2352x1568 · fundus photo · FOV: 45 degrees.
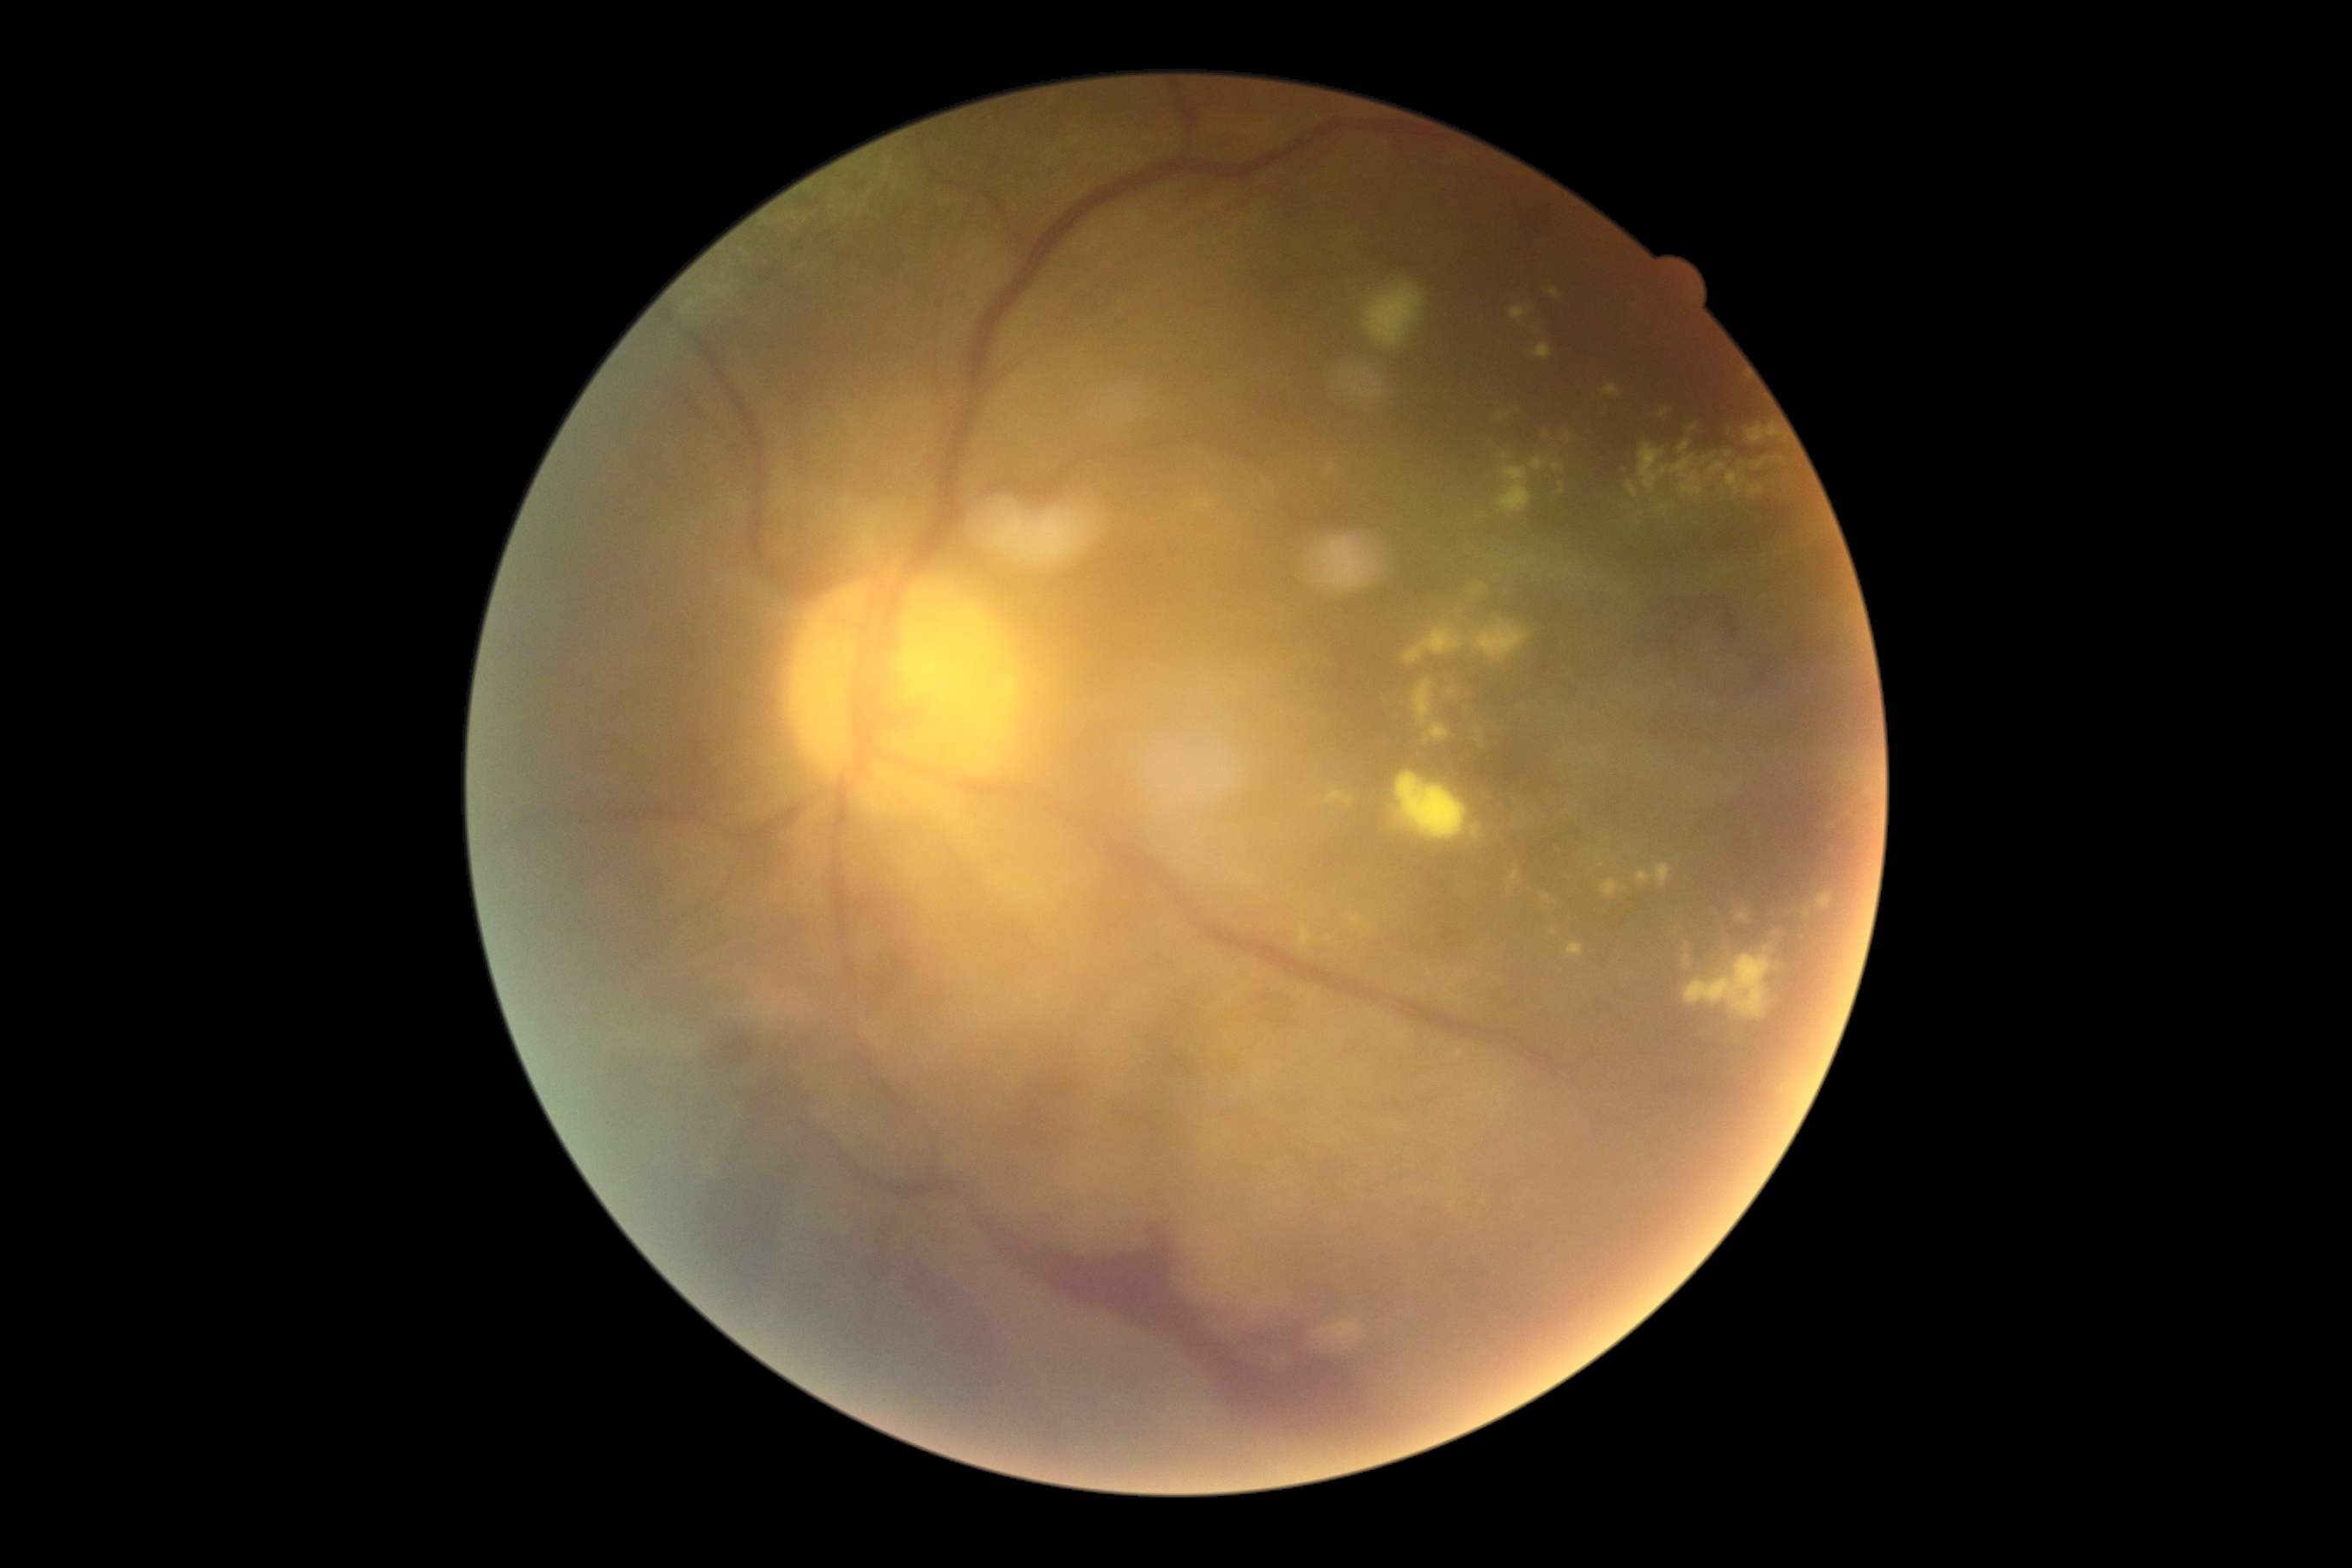 <lesions partial="true">
  <dr_grade>4</dr_grade>
  <ex partial="true">1545 288 1560 300 | 1301 924 1311 948 | 1727 472 1744 496 | 1749 486 1763 498 | 1660 505 1670 511 | 1404 627 1464 666 | 1316 790 1356 807 | 1478 584 1488 592 | 1682 946 1773 1019 | 1636 871 1651 885 | 1397 1032 1409 1041</ex>
  <ex_small_approx><pt>1494,1094</pt> | <pt>1329,939</pt> | <pt>1730,454</pt> | <pt>1686,948</pt> | <pt>1519,411</pt></ex_small_approx>
  <he>1385 247 1430 276 | 702 1026 766 1072 | 1734 628 1739 642 | 995 1216 1404 1457 | 1619 420 1732 451 | 1727 596 1732 625</he>
  <se>1366 283 1424 348</se>
  <ma />
</lesions>